Fundus photo.
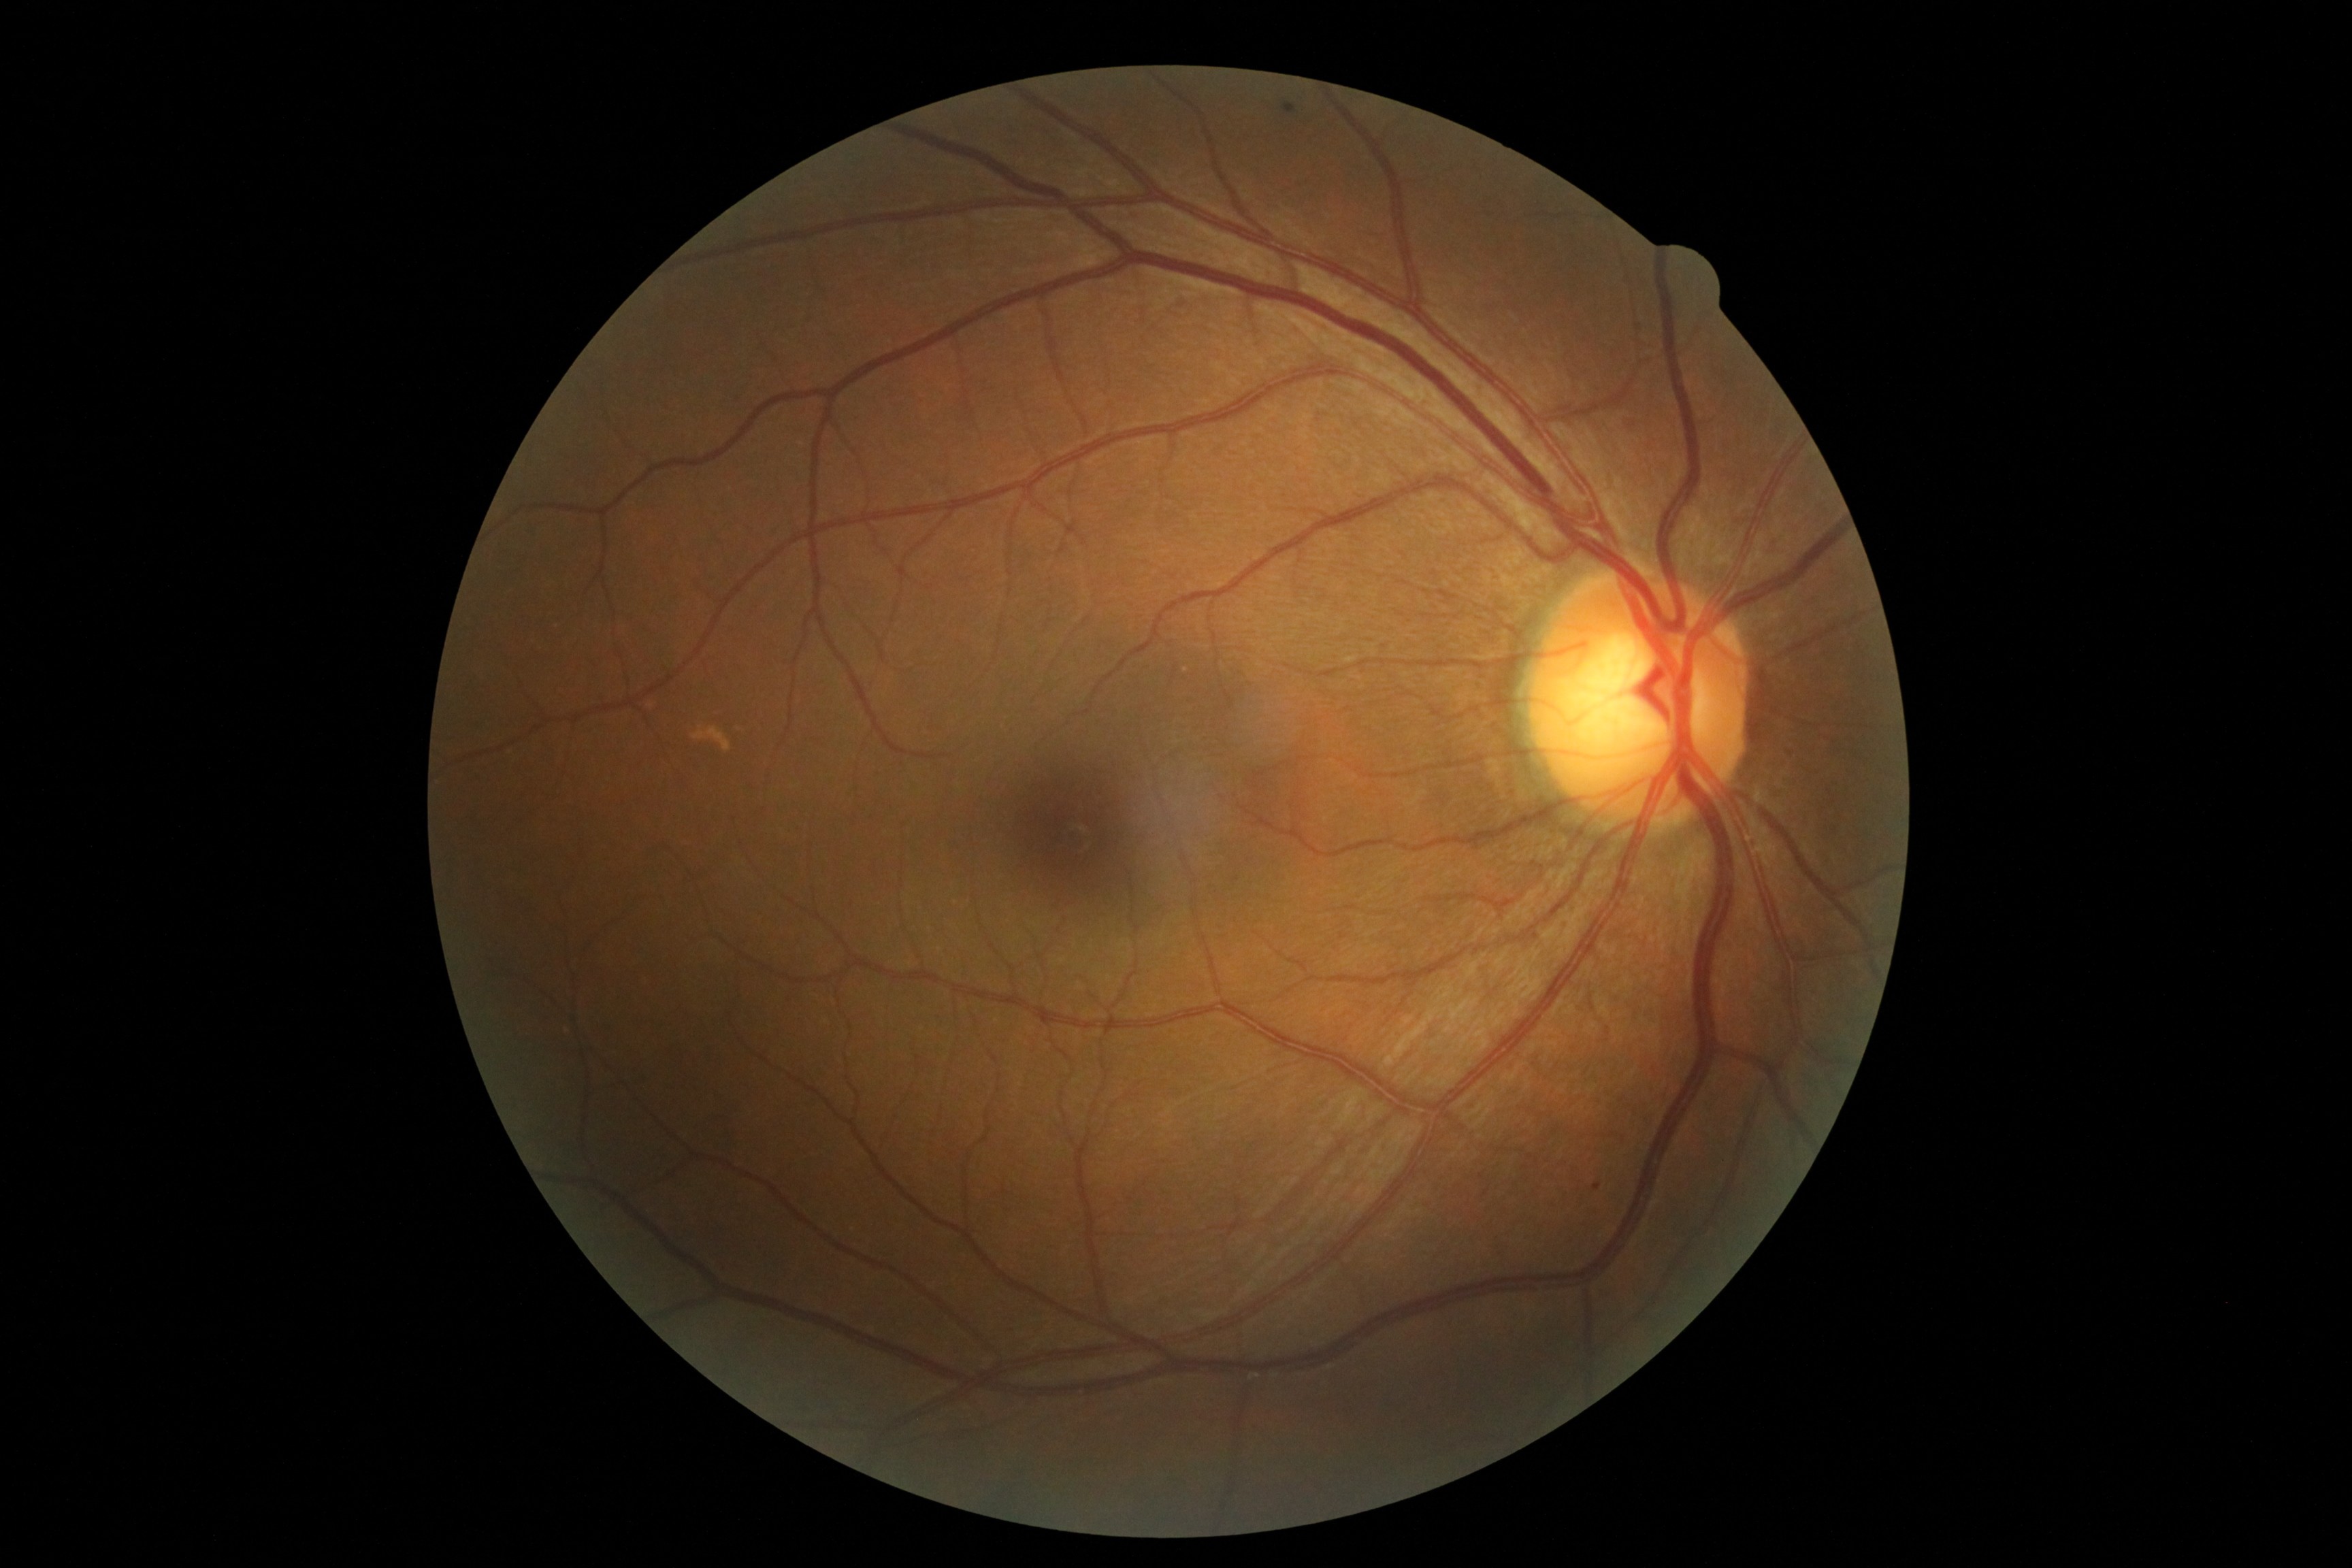
DR grade is 1/4.